Color fundus image, FOV: 45 degrees, 2352x1568
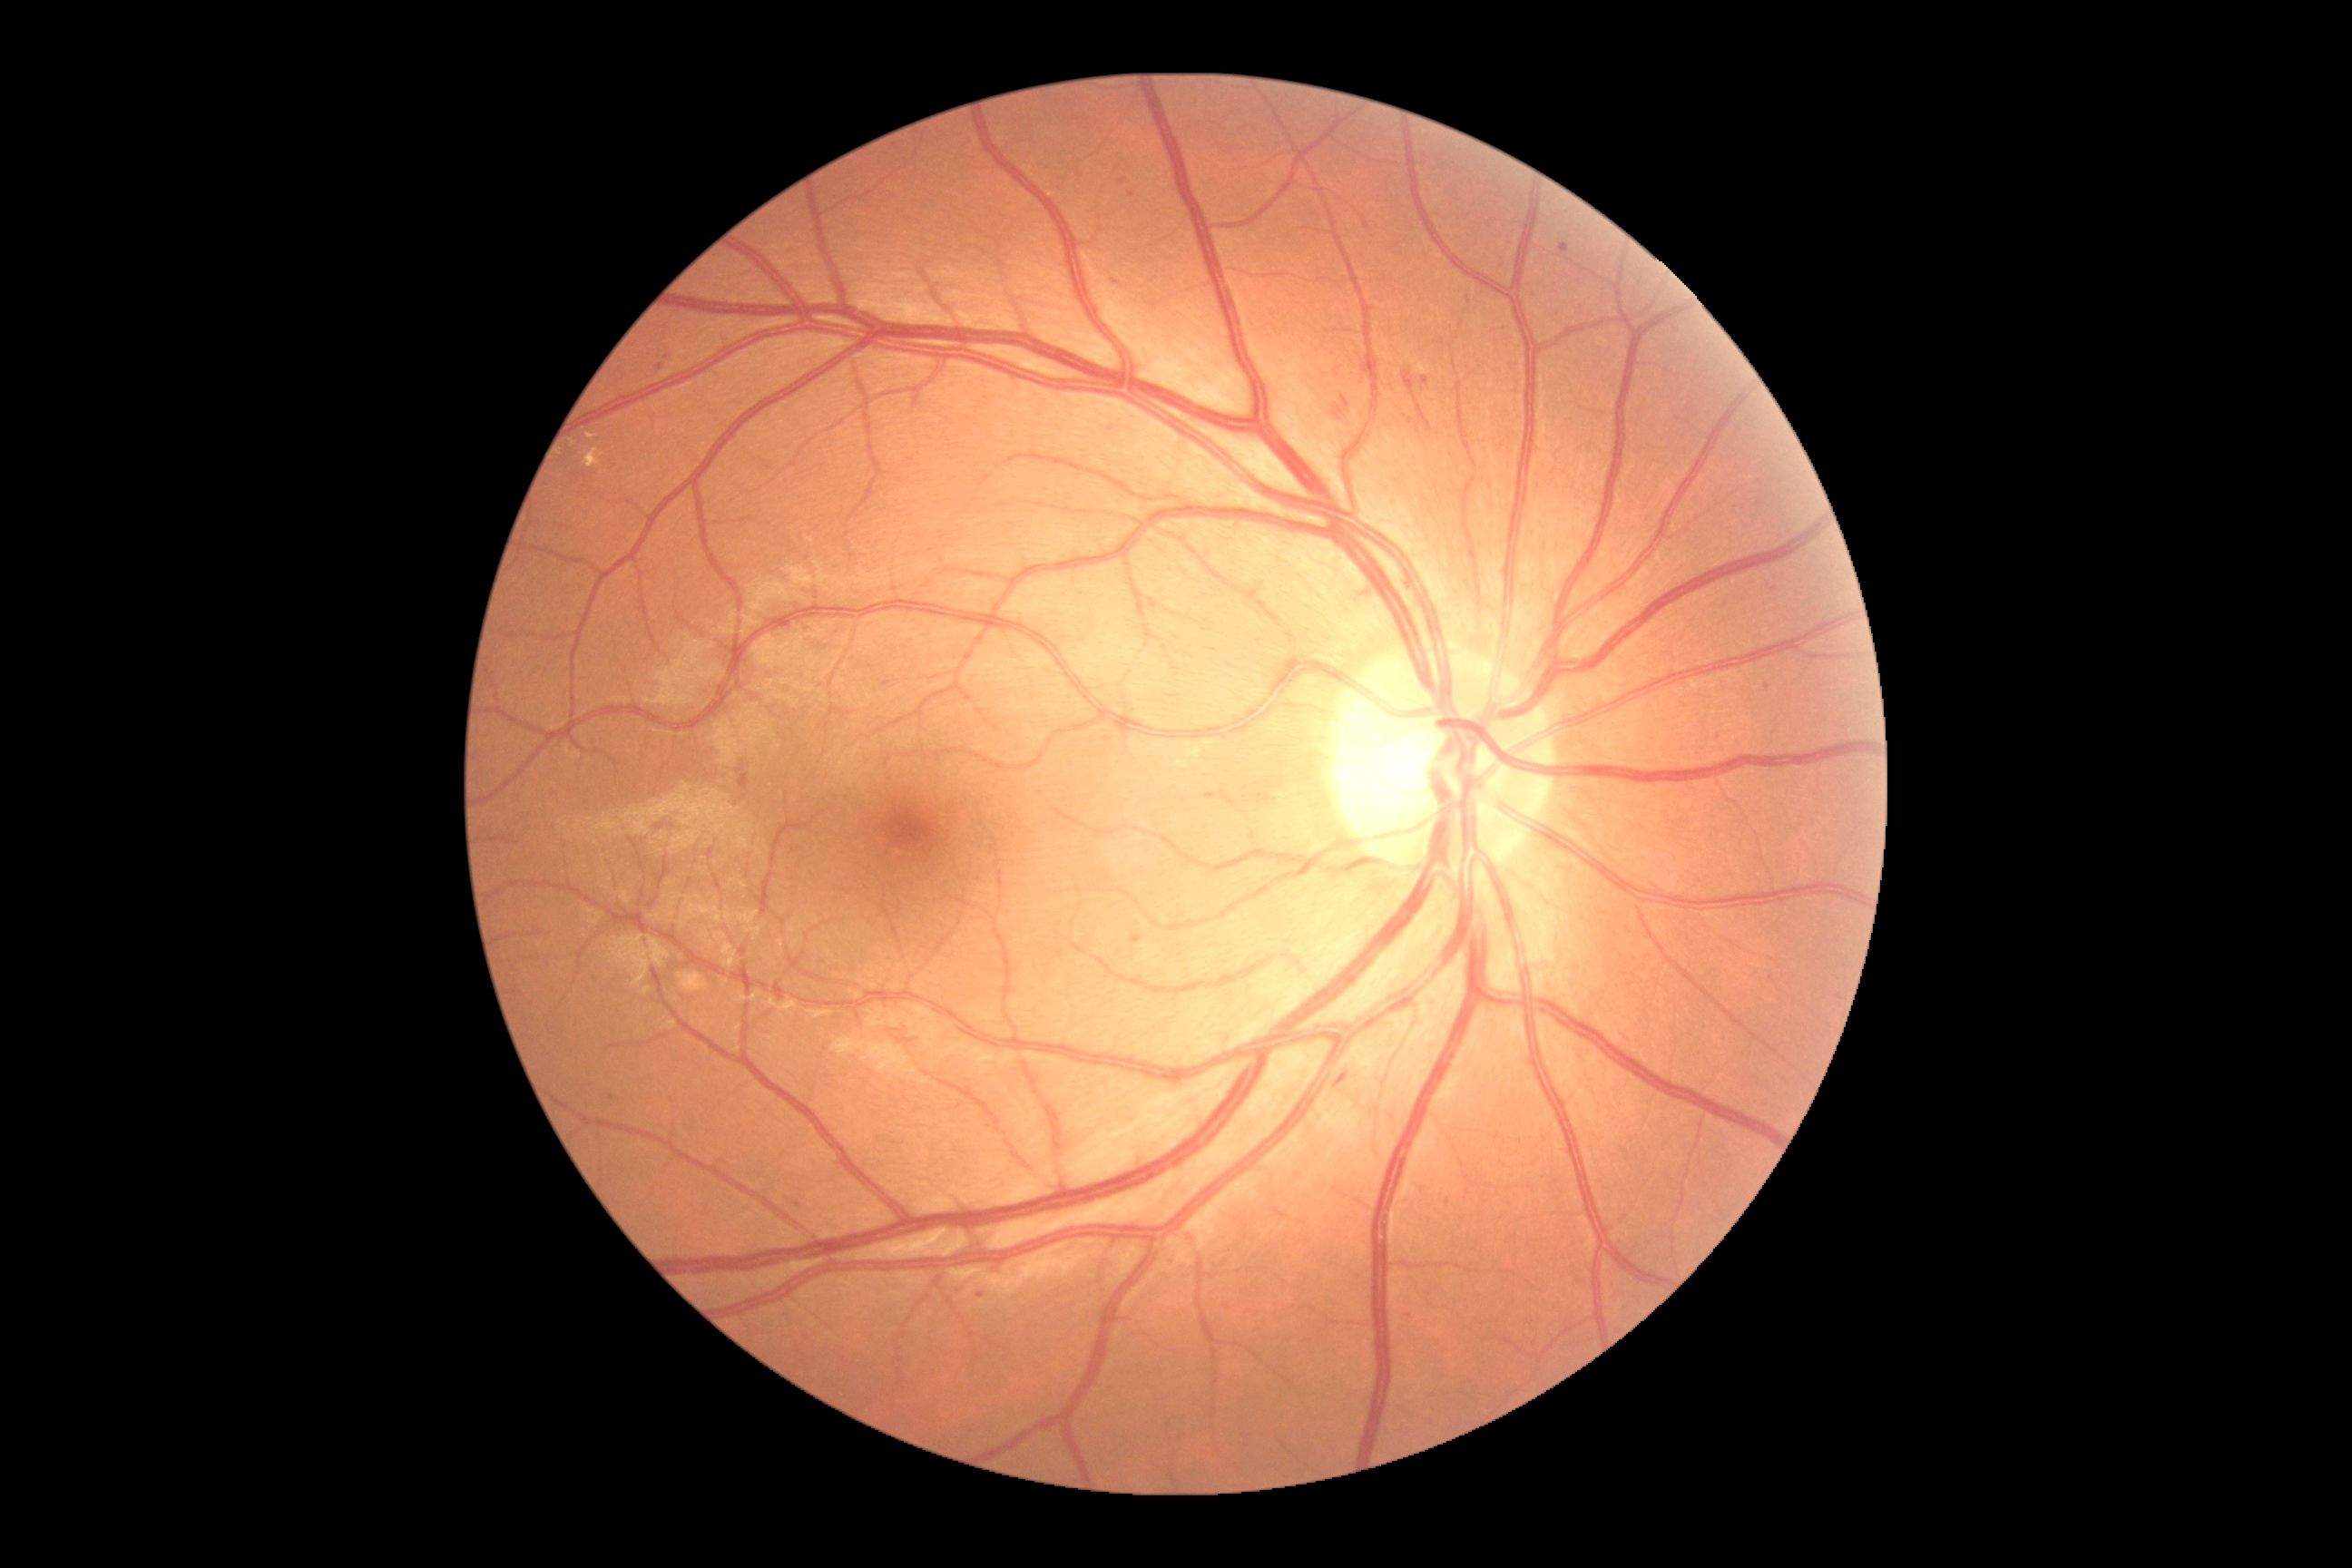 <lesions partial="true">
  <dr_grade>2</dr_grade>
  <ma partial="true">(x1=1758, y1=585, x2=1769, y2=593), (x1=1130, y1=936, x2=1142, y2=945), (x1=1208, y1=794, x2=1217, y2=803), (x1=1422, y1=378, x2=1429, y2=386), (x1=1533, y1=297, x2=1542, y2=304)</ma>
  <ma_small>point(1767, 688), point(1116, 283), point(667, 358), point(798, 1205), point(613, 1098)</ma_small>
</lesions>